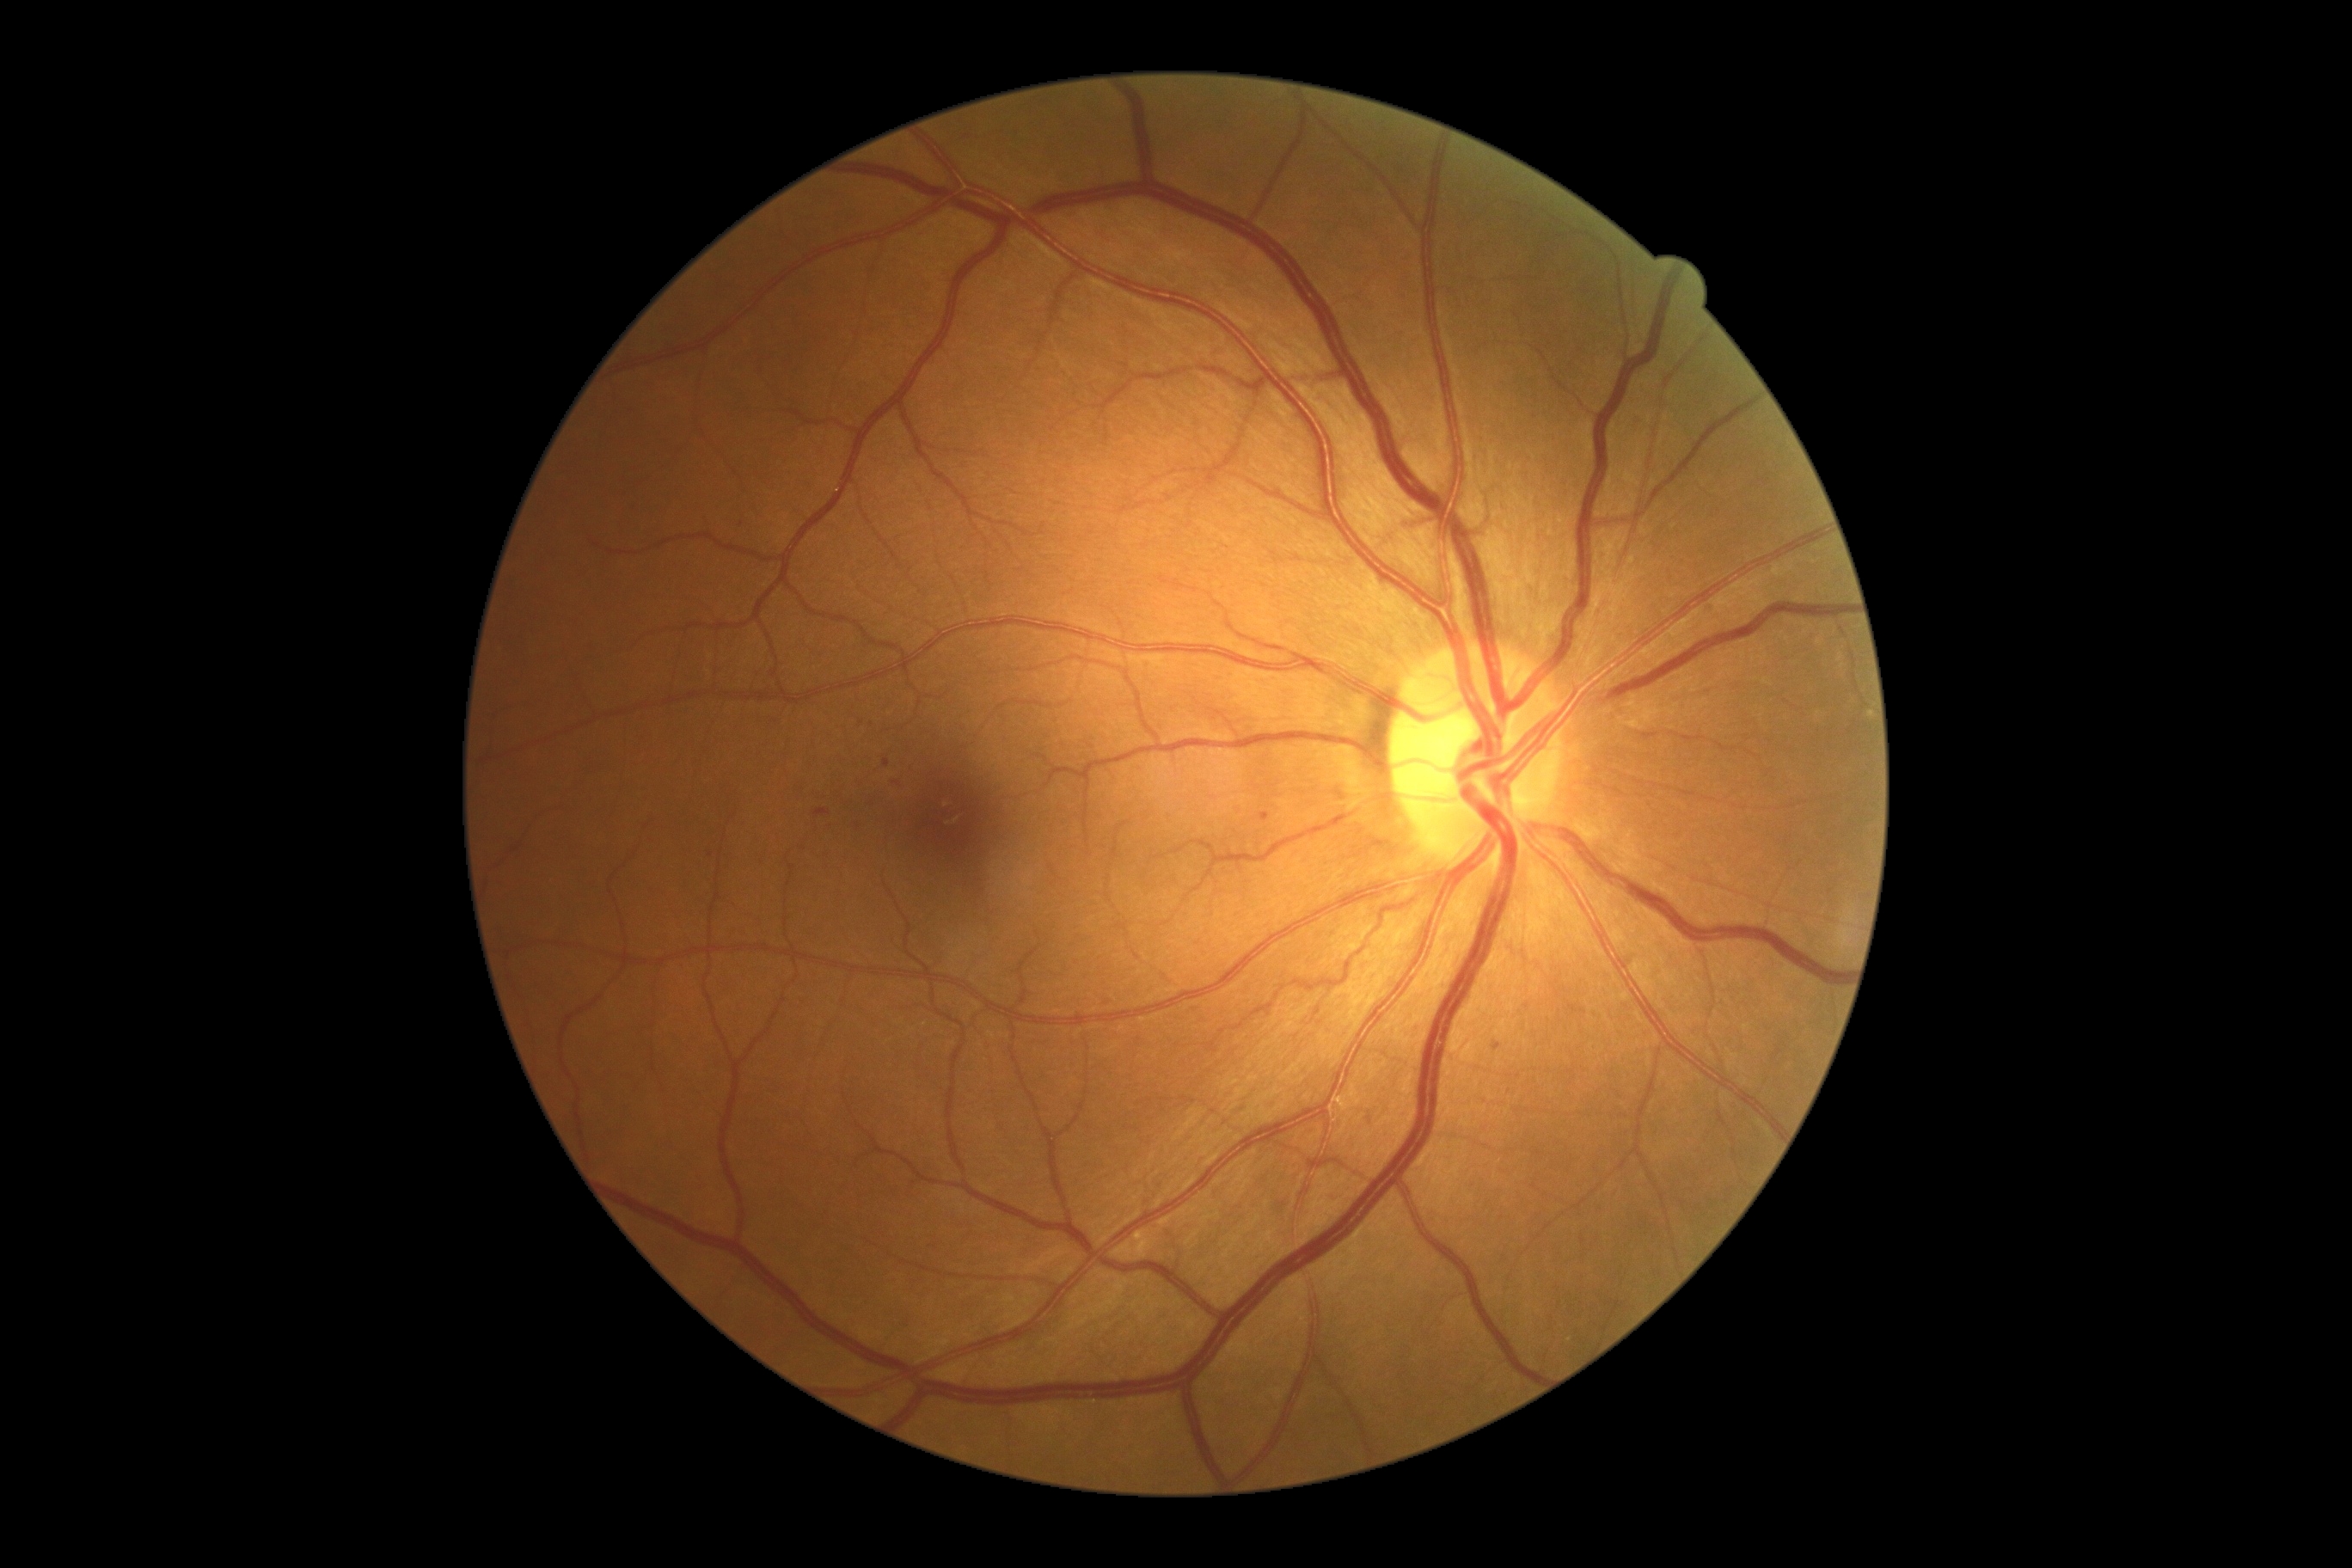 DR: grade 1 (mild NPDR)
HEs = none
MAs = [1491, 1043, 1502, 1051], [883, 759, 890, 768], [814, 809, 831, 819], [1259, 812, 1270, 823]
Smaller MAs around x=897, y=785, x=711, y=854, x=859, y=828
EXs = none
SEs = none